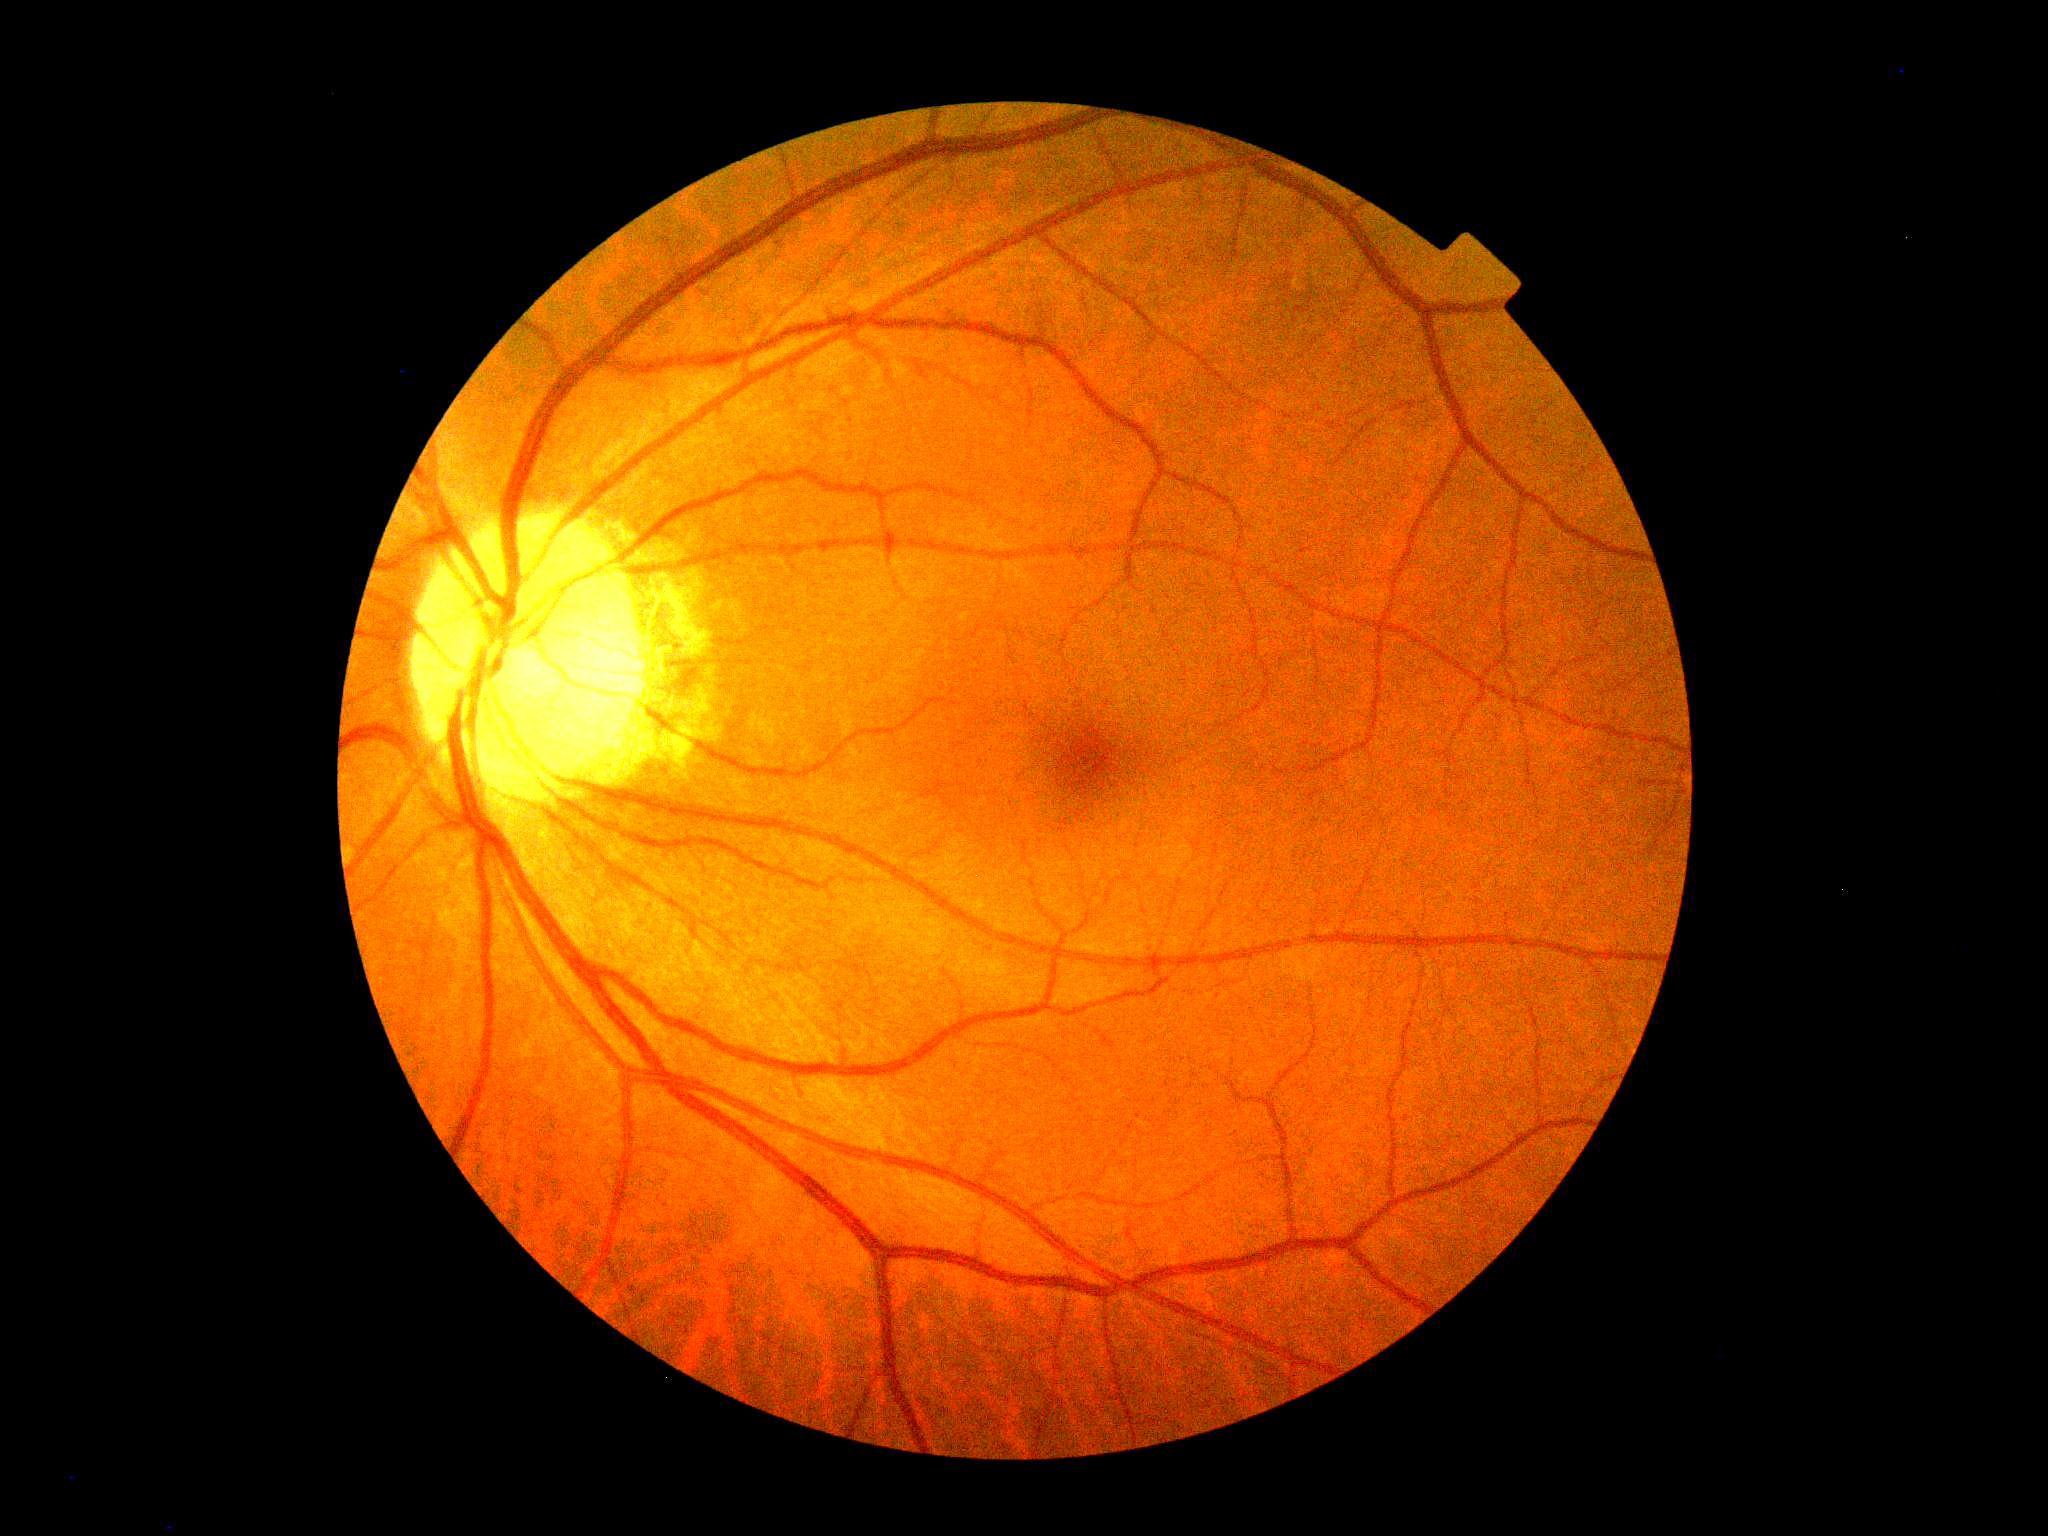

  dr_impression: no apparent DR
  dr_grade: no apparent retinopathy (grade 0) — no visible signs of diabetic retinopathy